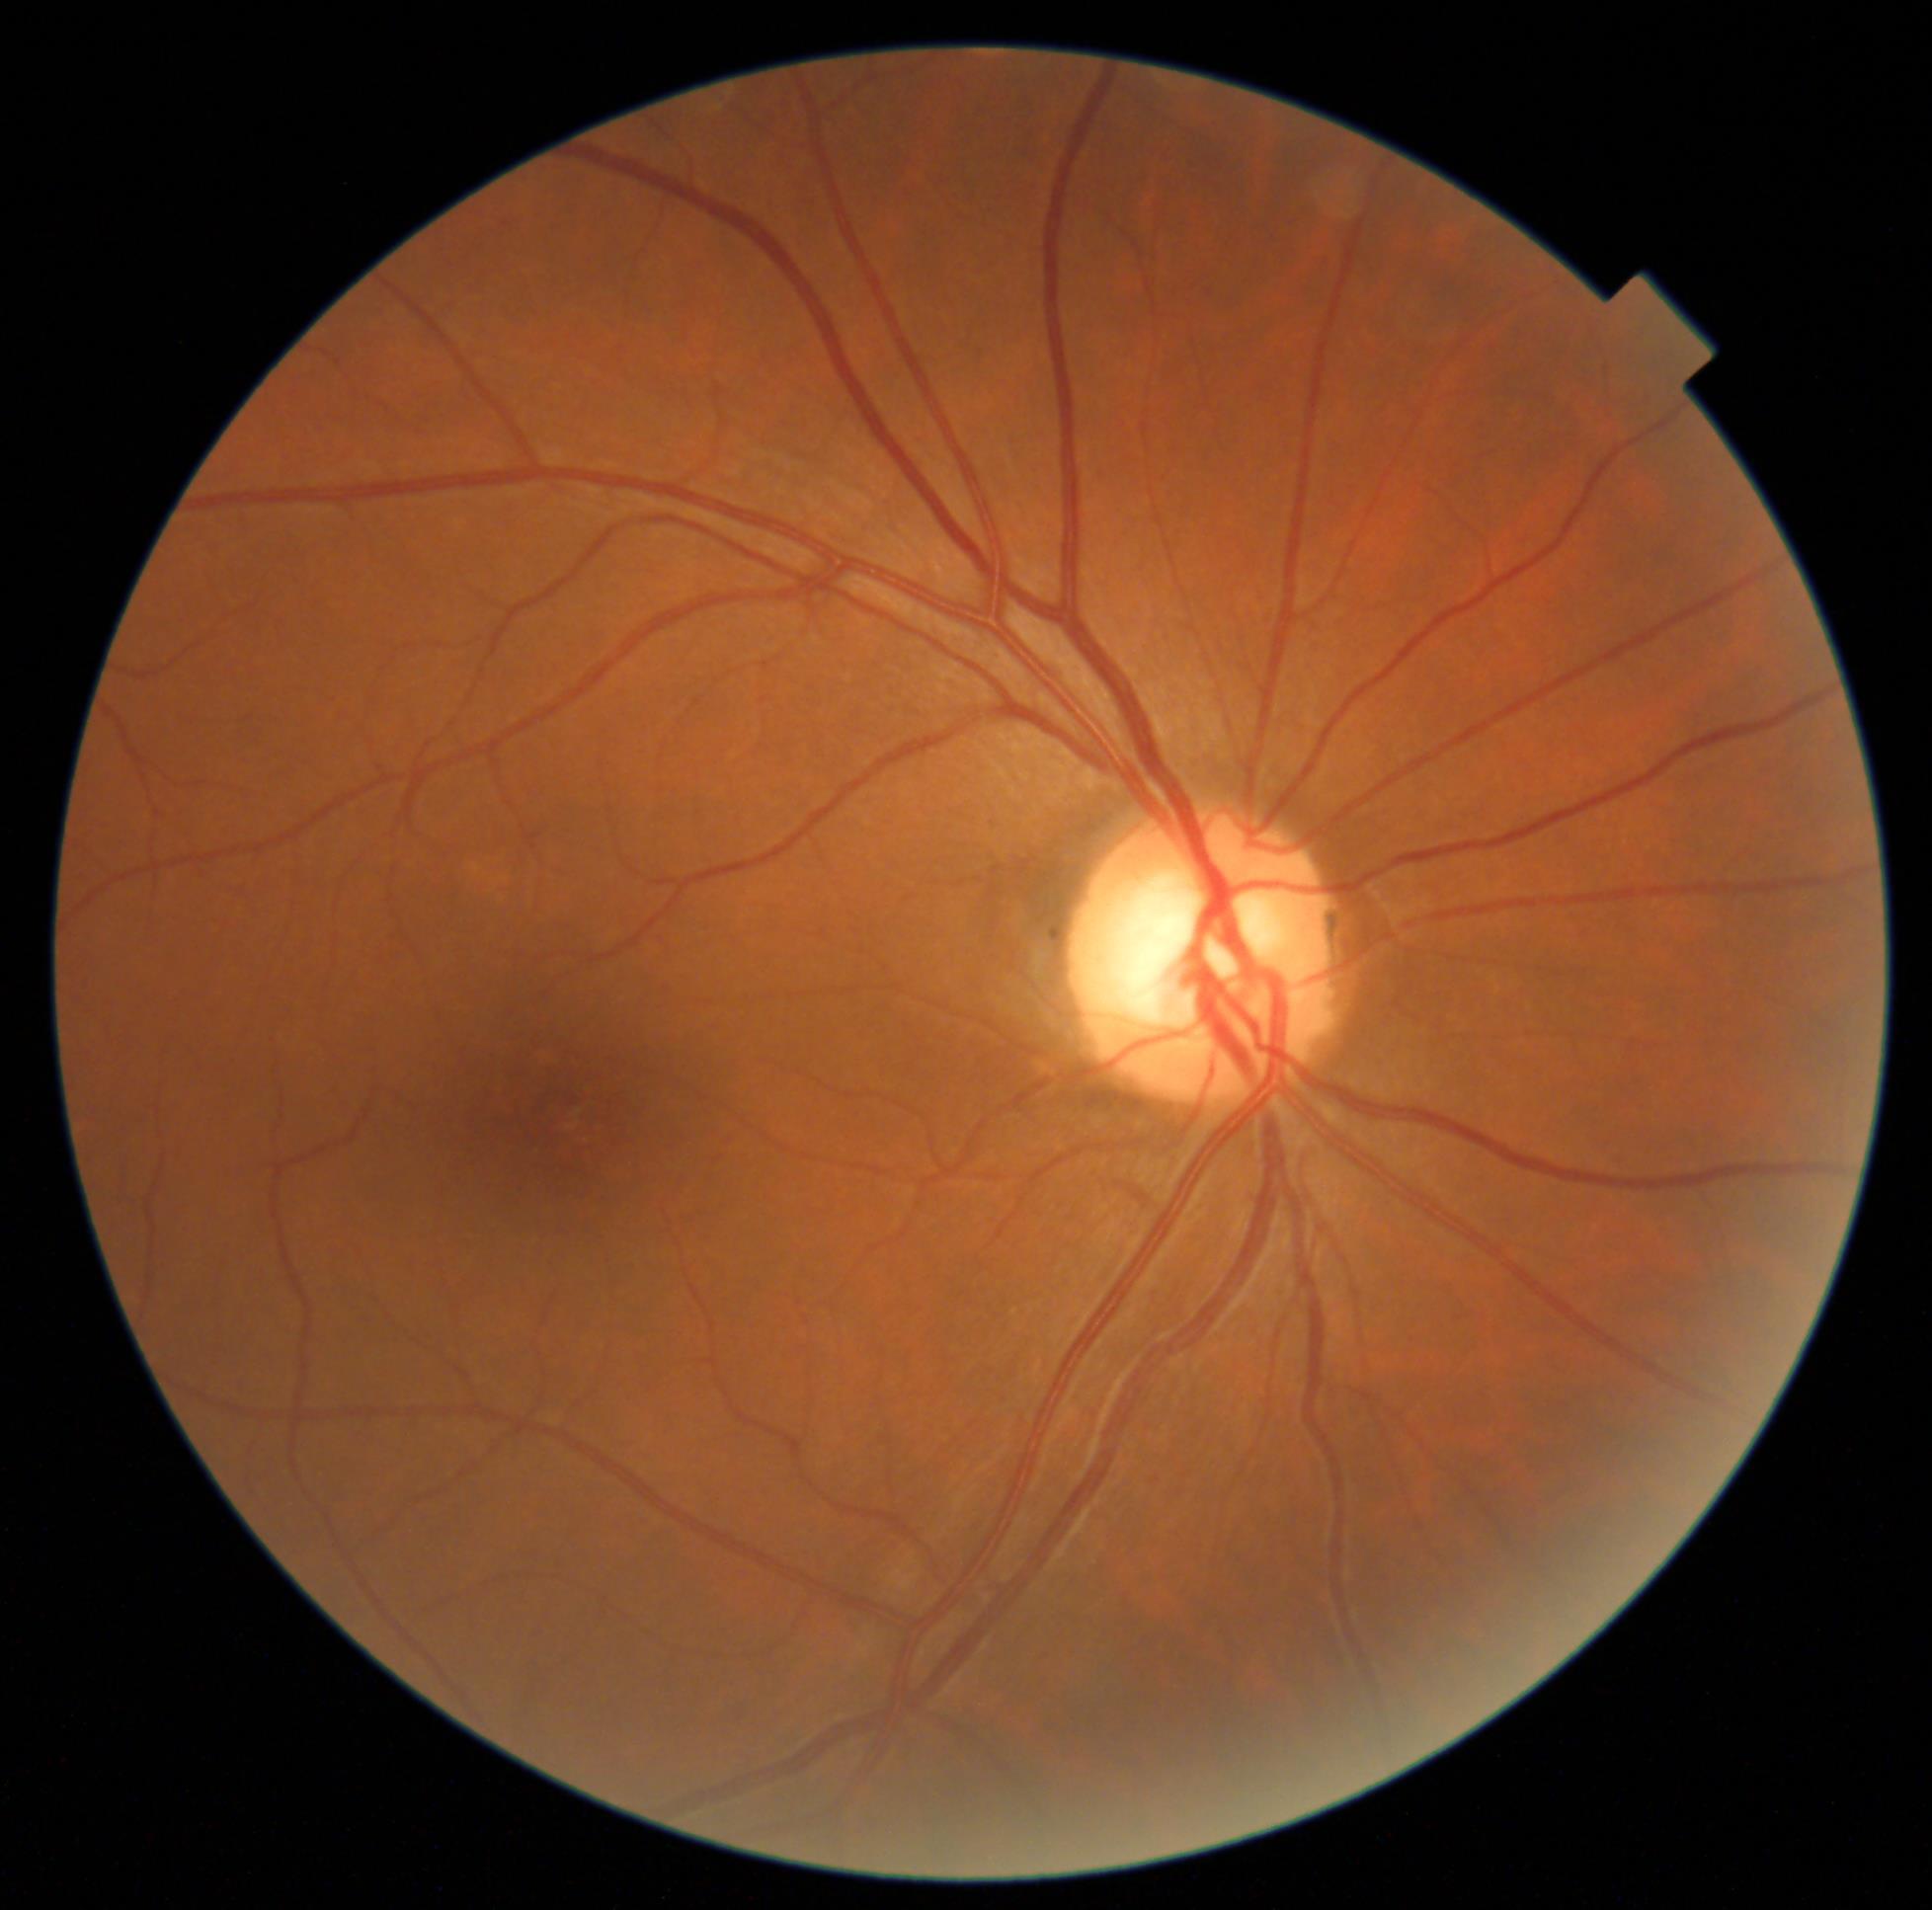
DR grade is 0 (no apparent retinopathy).